Modified Davis classification; no pharmacologic dilation; color fundus image; 45° FOV:
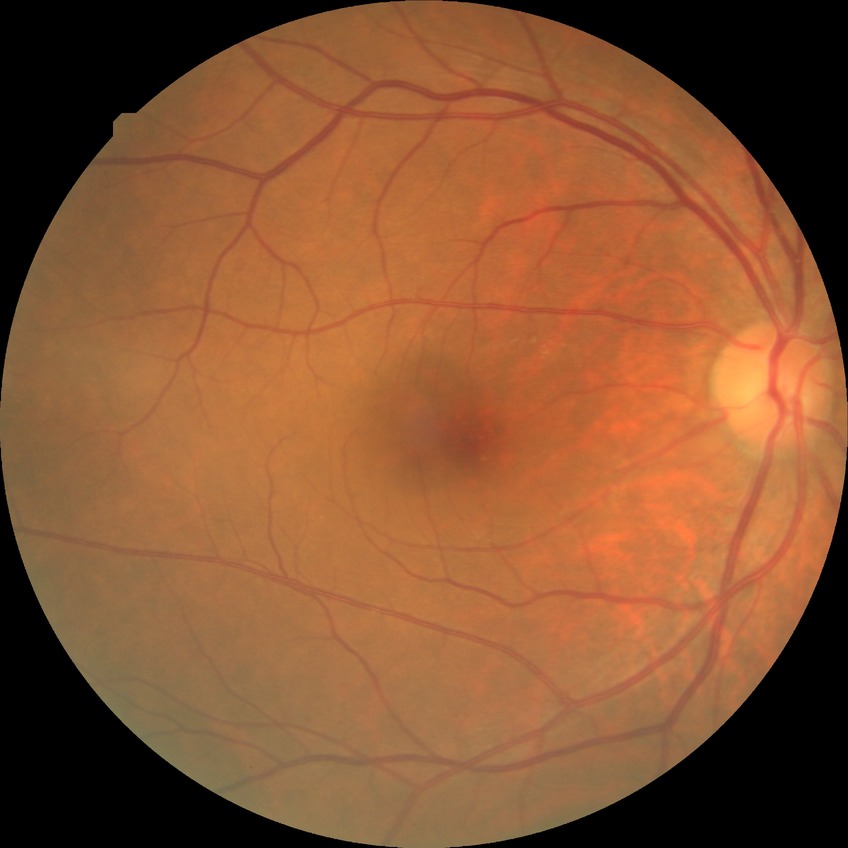

Diabetic retinopathy (DR) is NDR (no diabetic retinopathy).